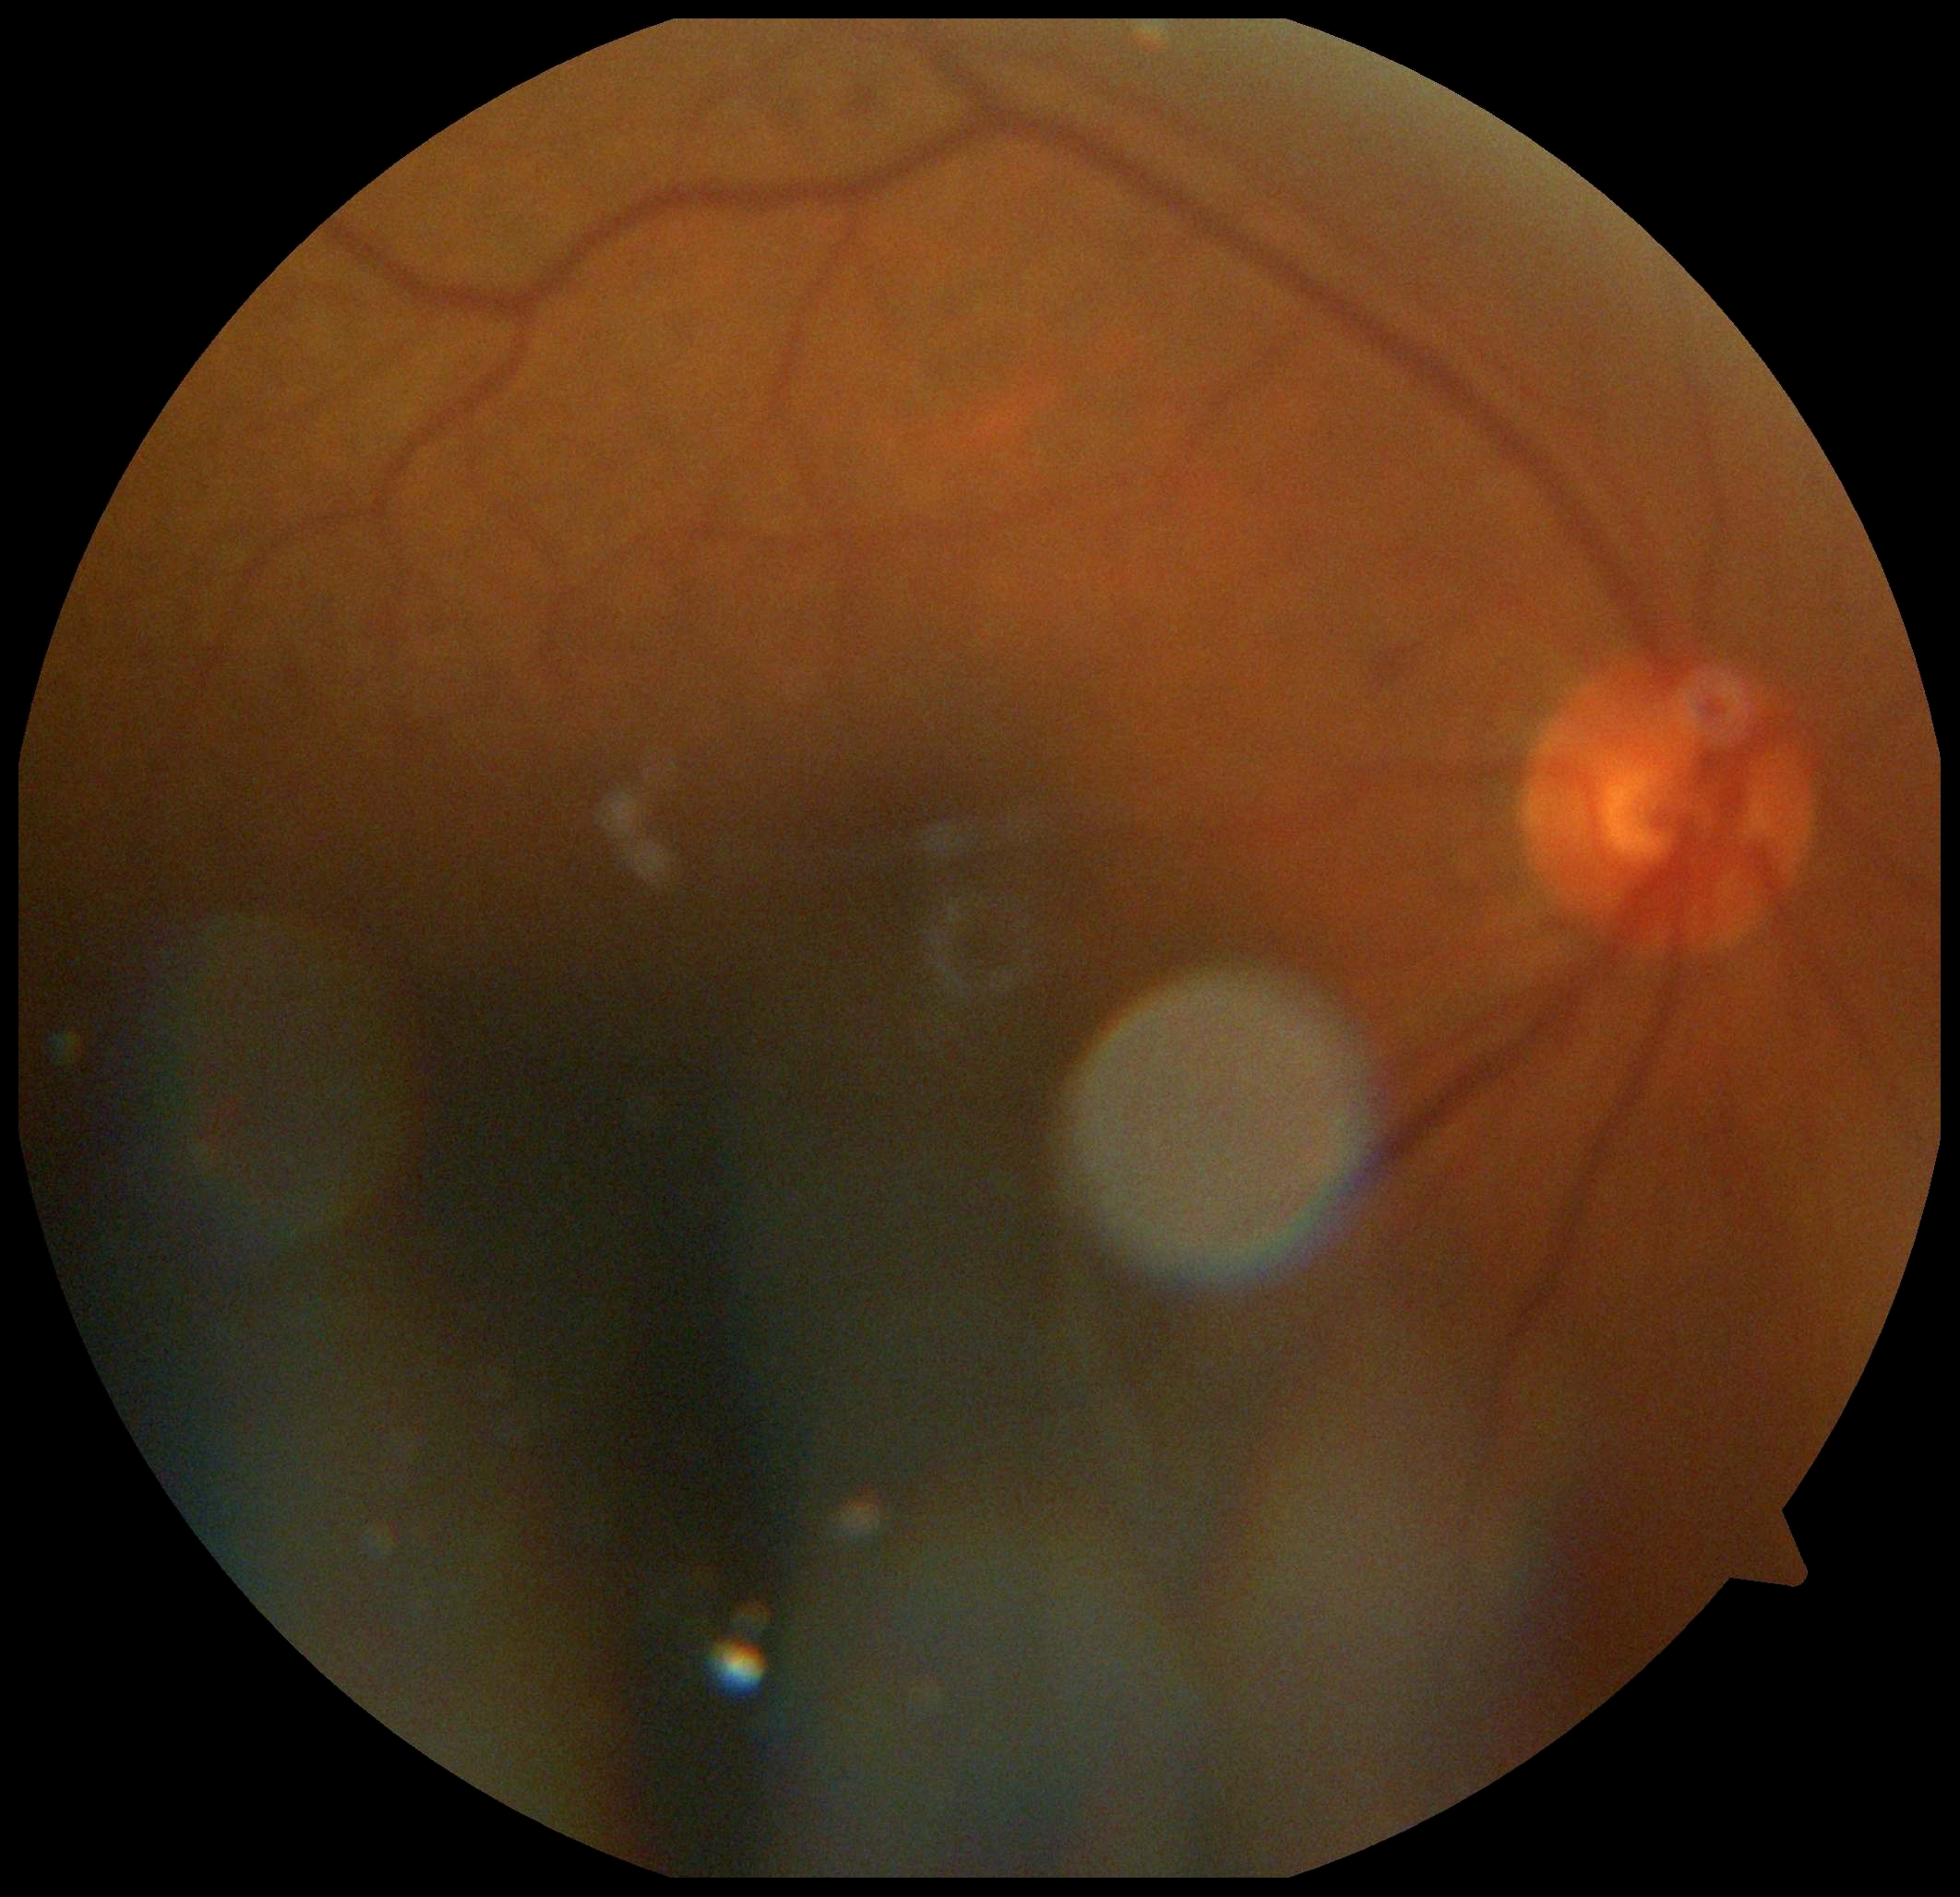 diabetic retinopathy grade = moderate NPDR (2) | DR class = non-proliferative diabetic retinopathy.